Retinal fundus photograph. 1470 x 1137 pixels:
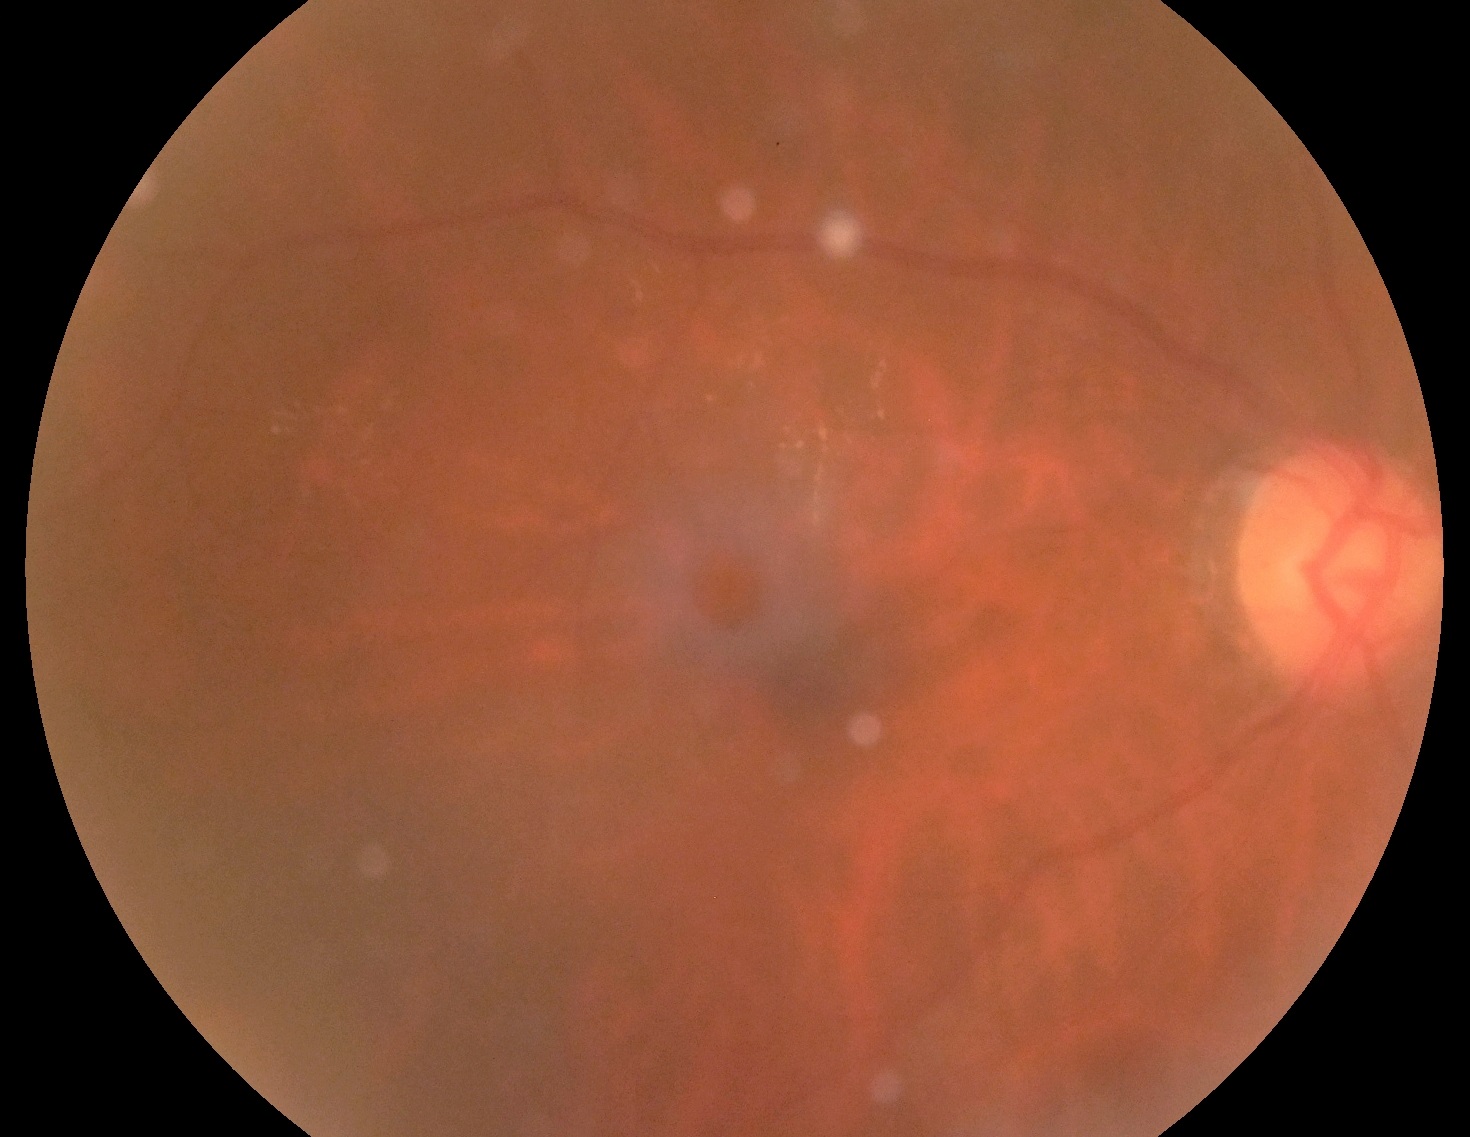
Disease class: non-proliferative diabetic retinopathy.
Diabetic retinopathy (DR) is moderate NPDR (grade 2).